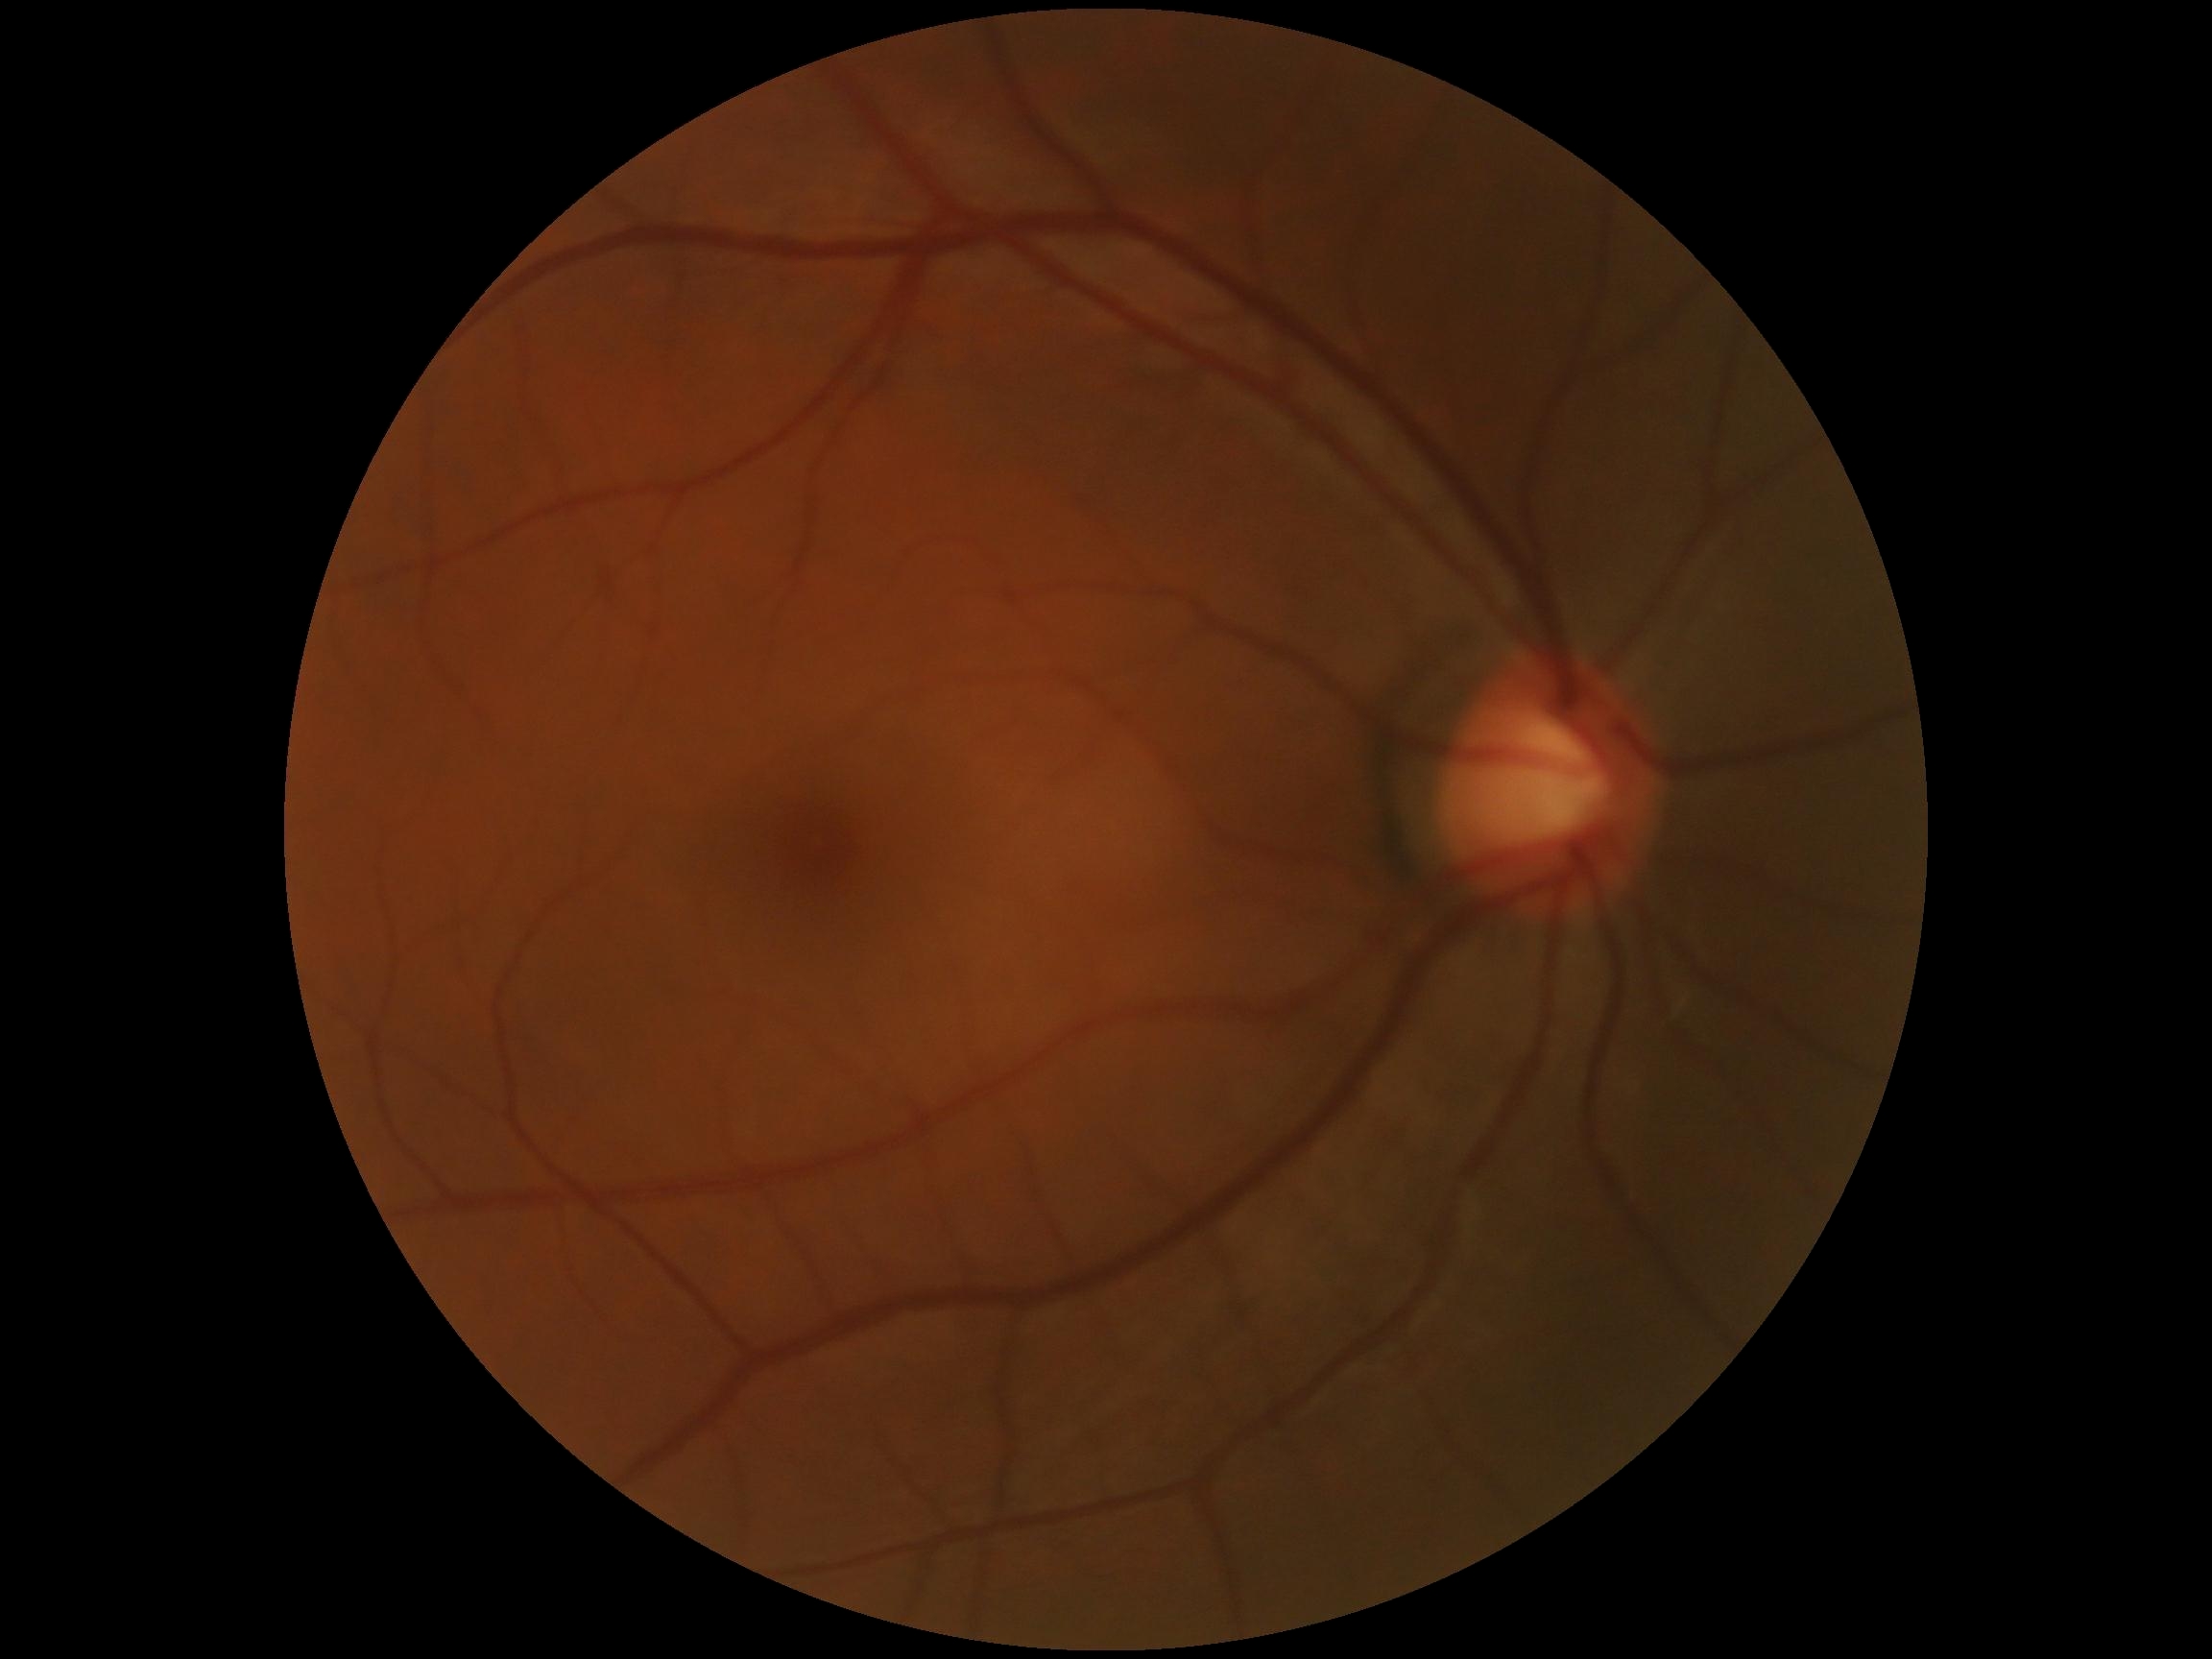
dr_grade: 0/4
dr_impression: no signs of DR